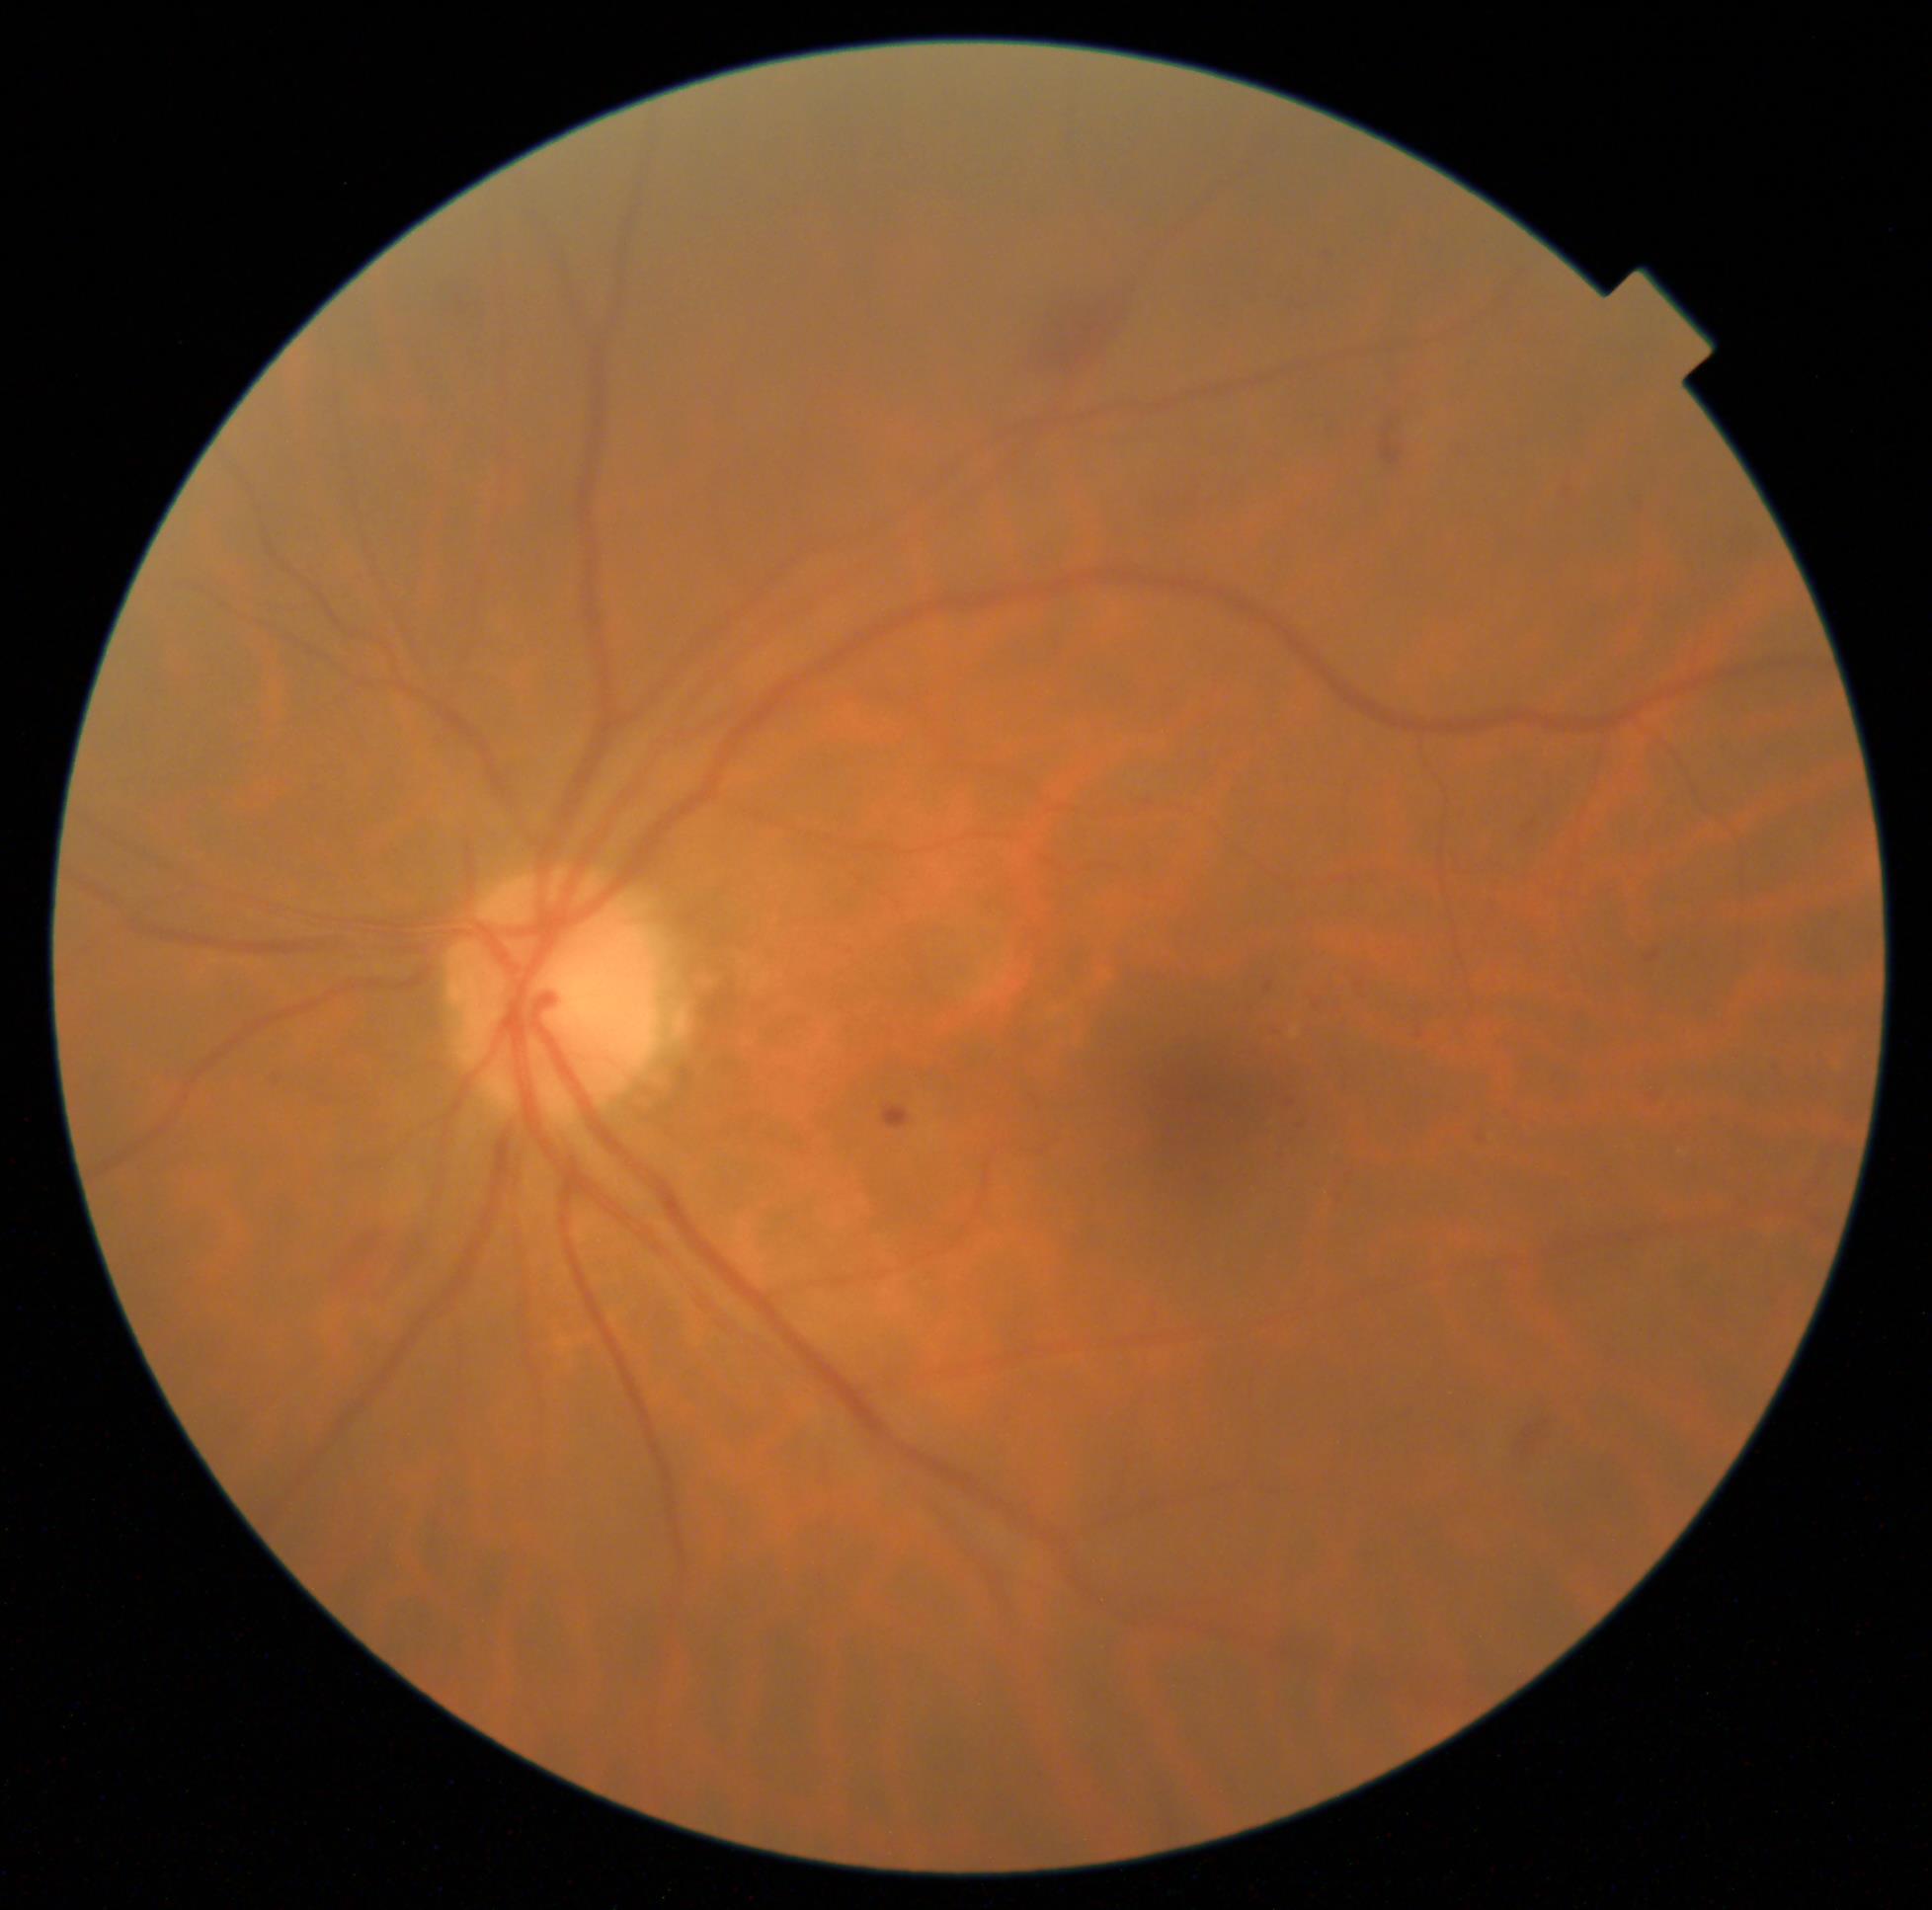 {"dr_grade": "moderate NPDR (grade 2)"}